45-degree field of view:
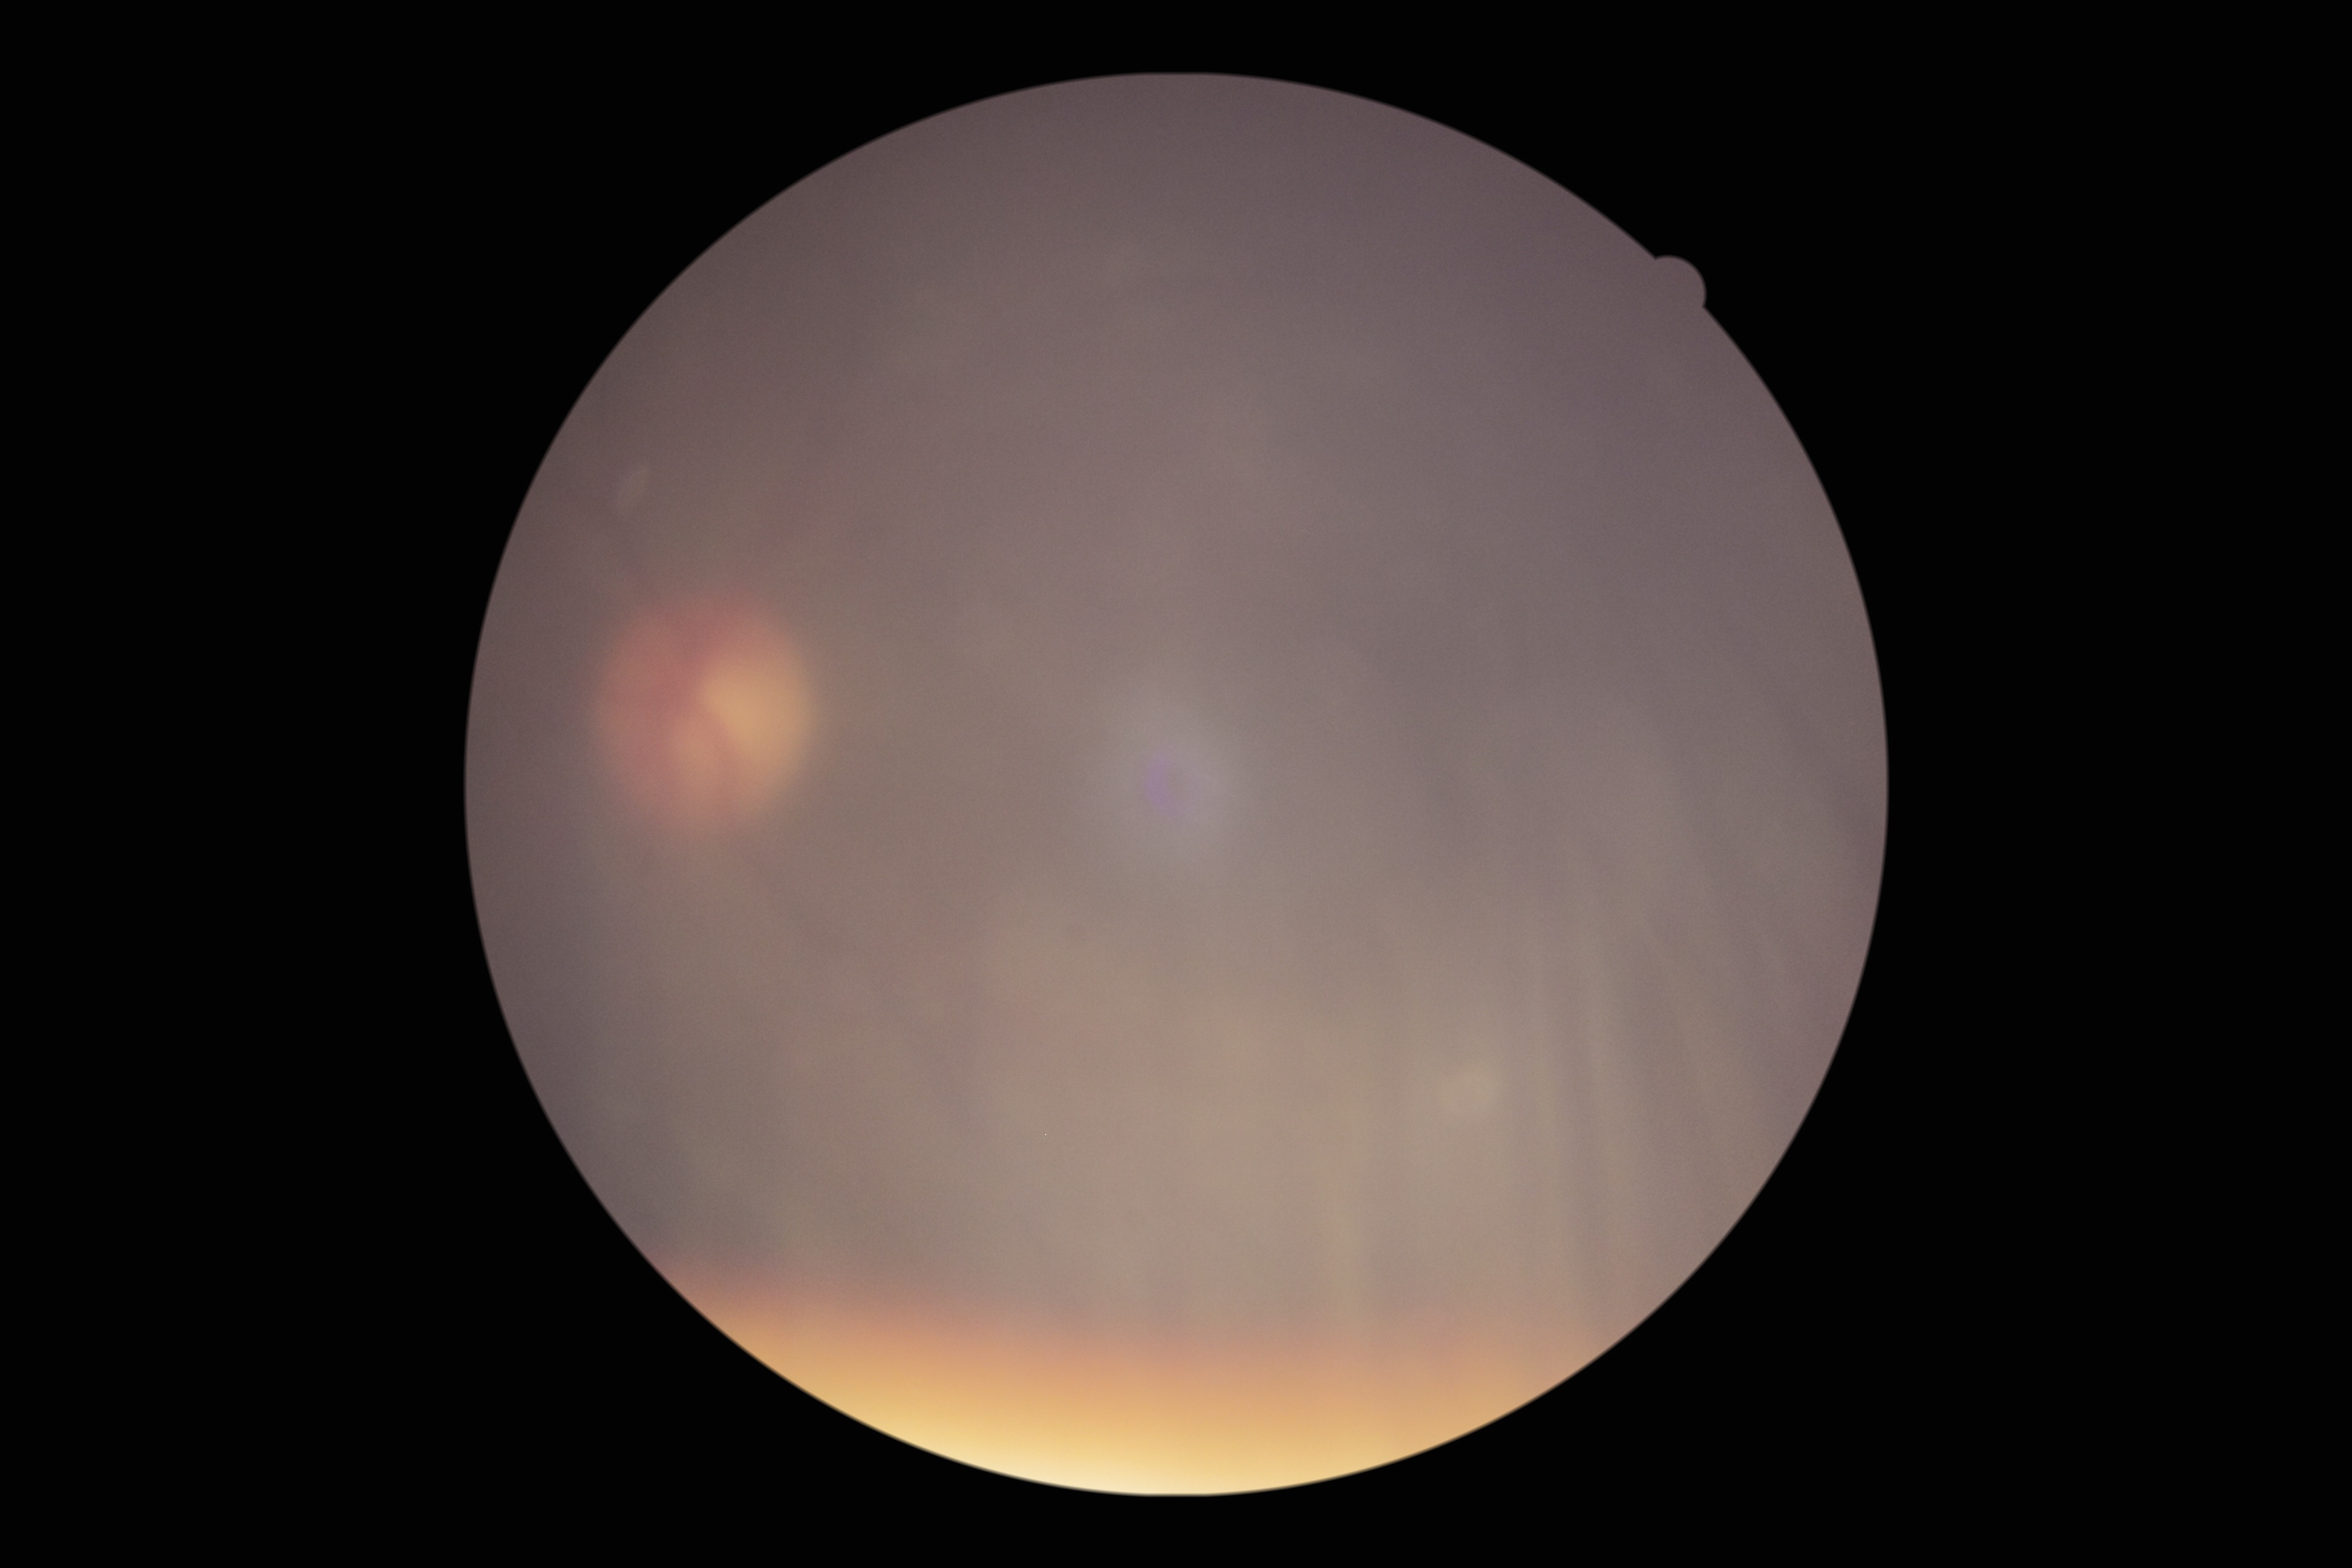

Findings:
– retinopathy grade: ungradable due to poor image quality
– image quality: insufficient for DR assessment